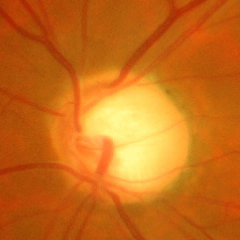 Color fundus photograph showing advanced-stage glaucoma.